NIDEK AFC-230 fundus camera · graded on the modified Davis scale:
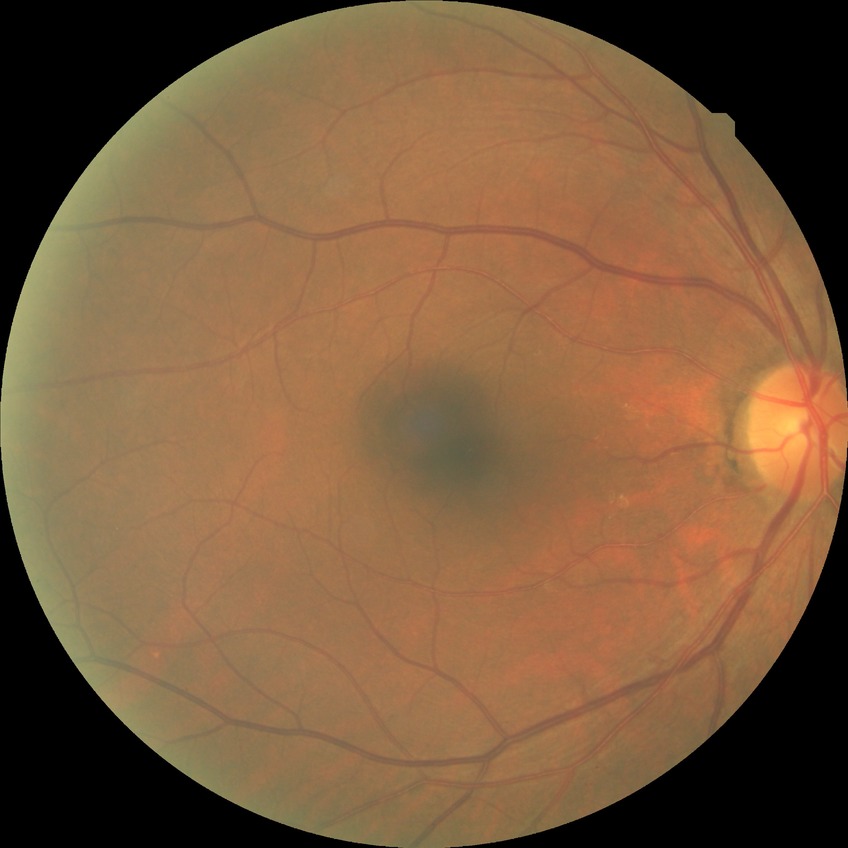
Assessment:
* diabetic retinopathy (DR) — NDR (no diabetic retinopathy)